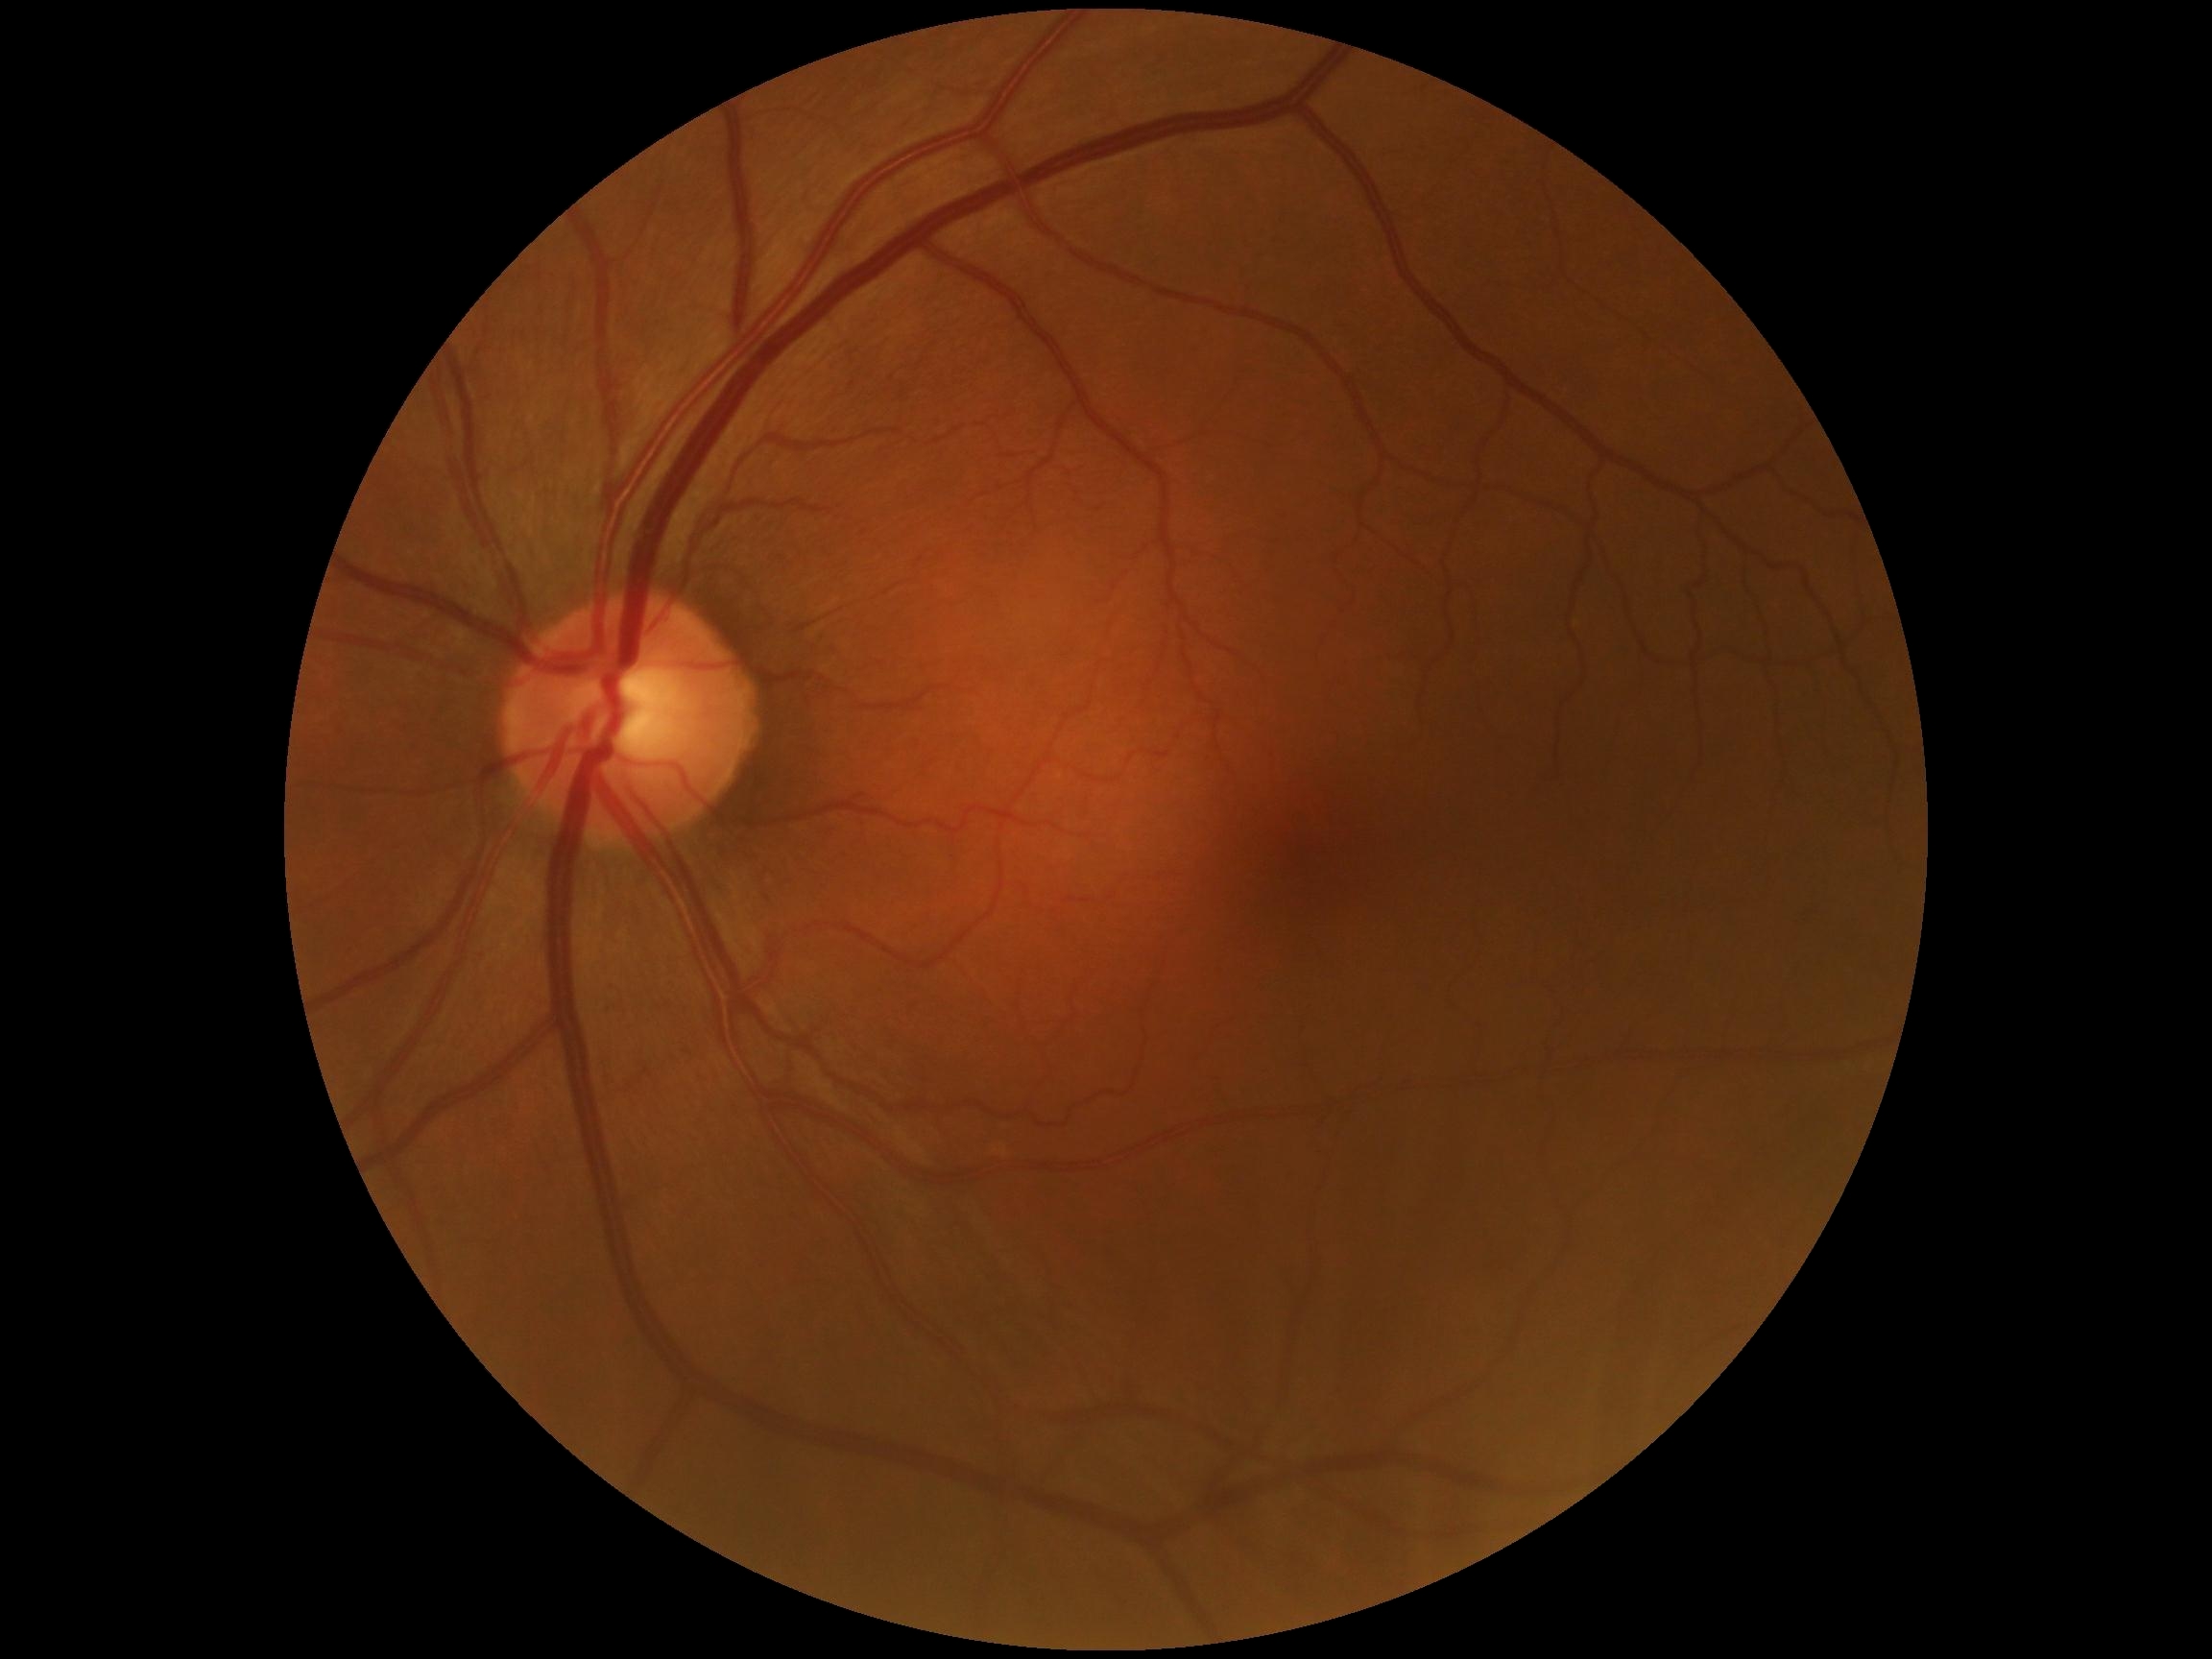

DR grade is 0 (no apparent retinopathy).